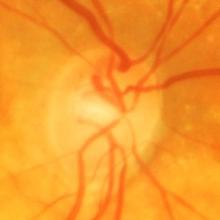 Diagnosis = glaucomatous optic neuropathy.